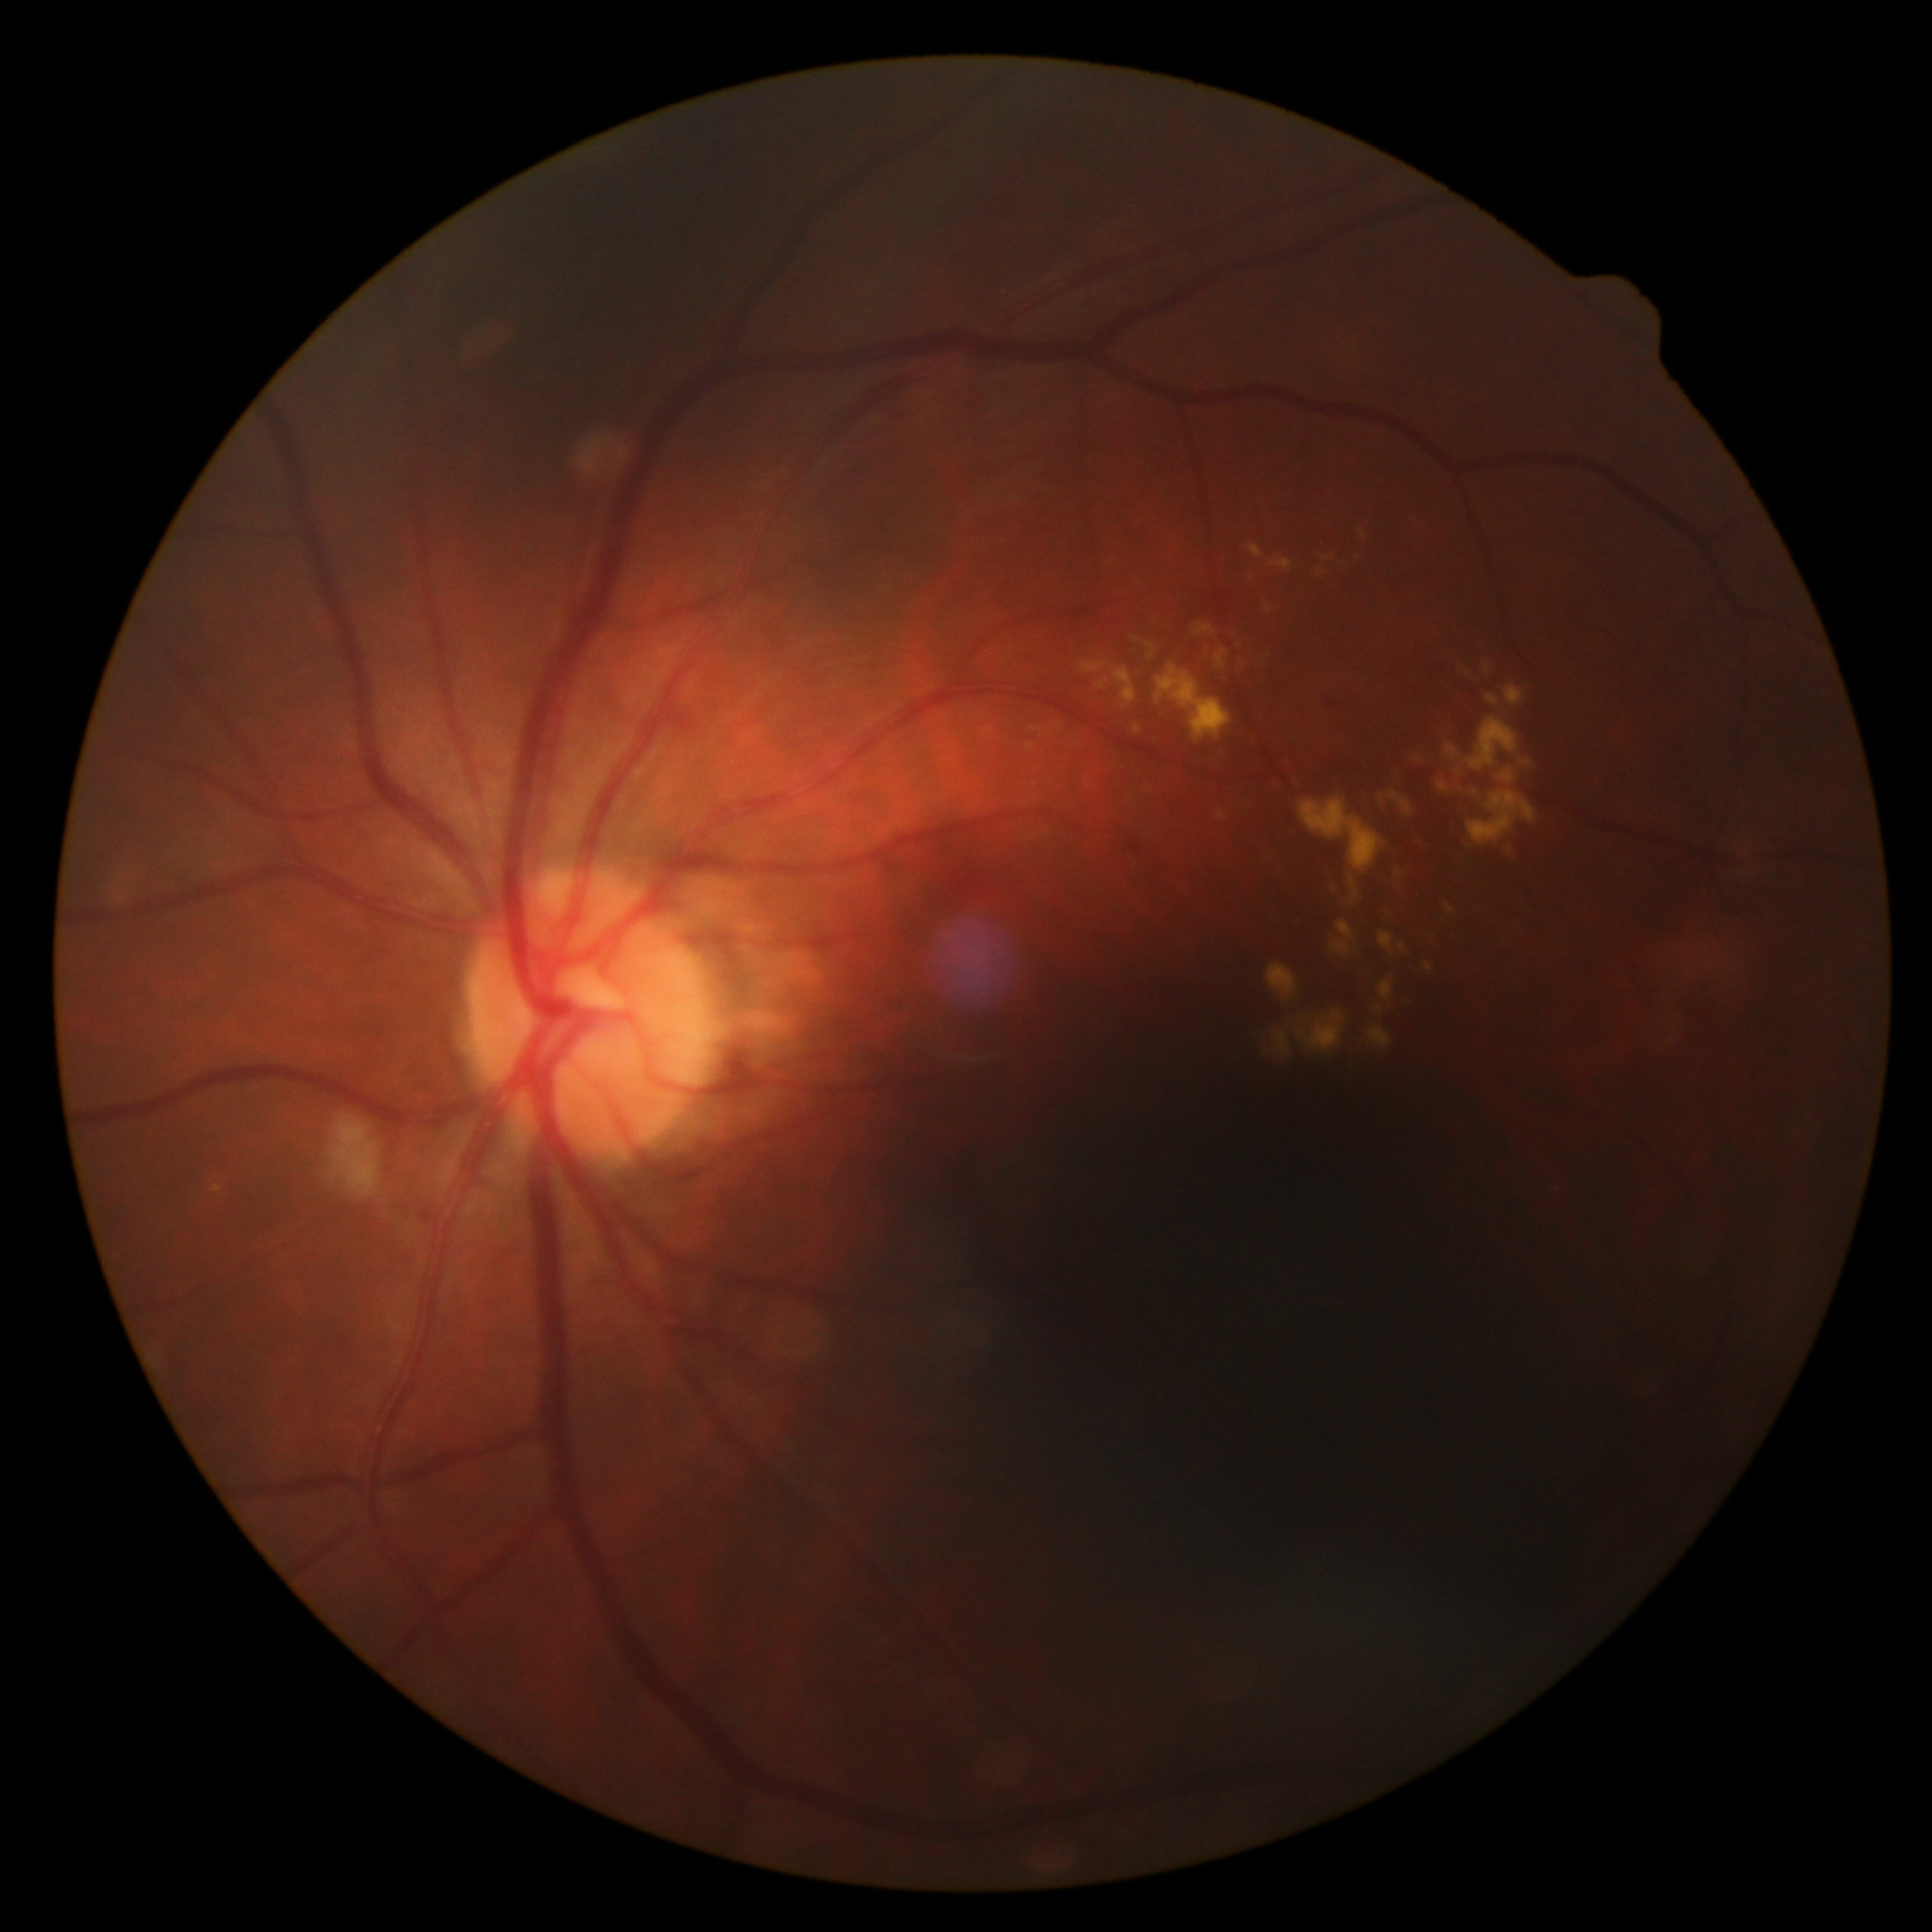
diabetic retinopathy severity: moderate NPDR (grade 2) — more than just microaneurysms but less than severe NPDR.